DR severity per modified Davis staging; acquired with a NIDEK AFC-230: 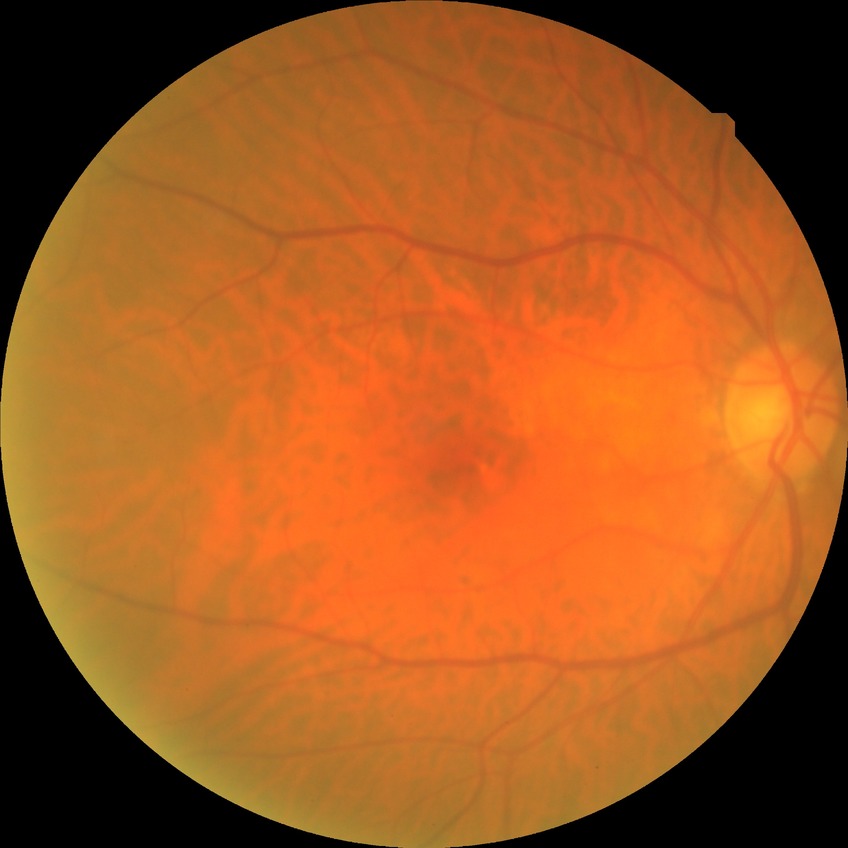 Modified Davis classification: no diabetic retinopathy.